CFP, image size 1659x2212, Remidio FOP fundus camera.
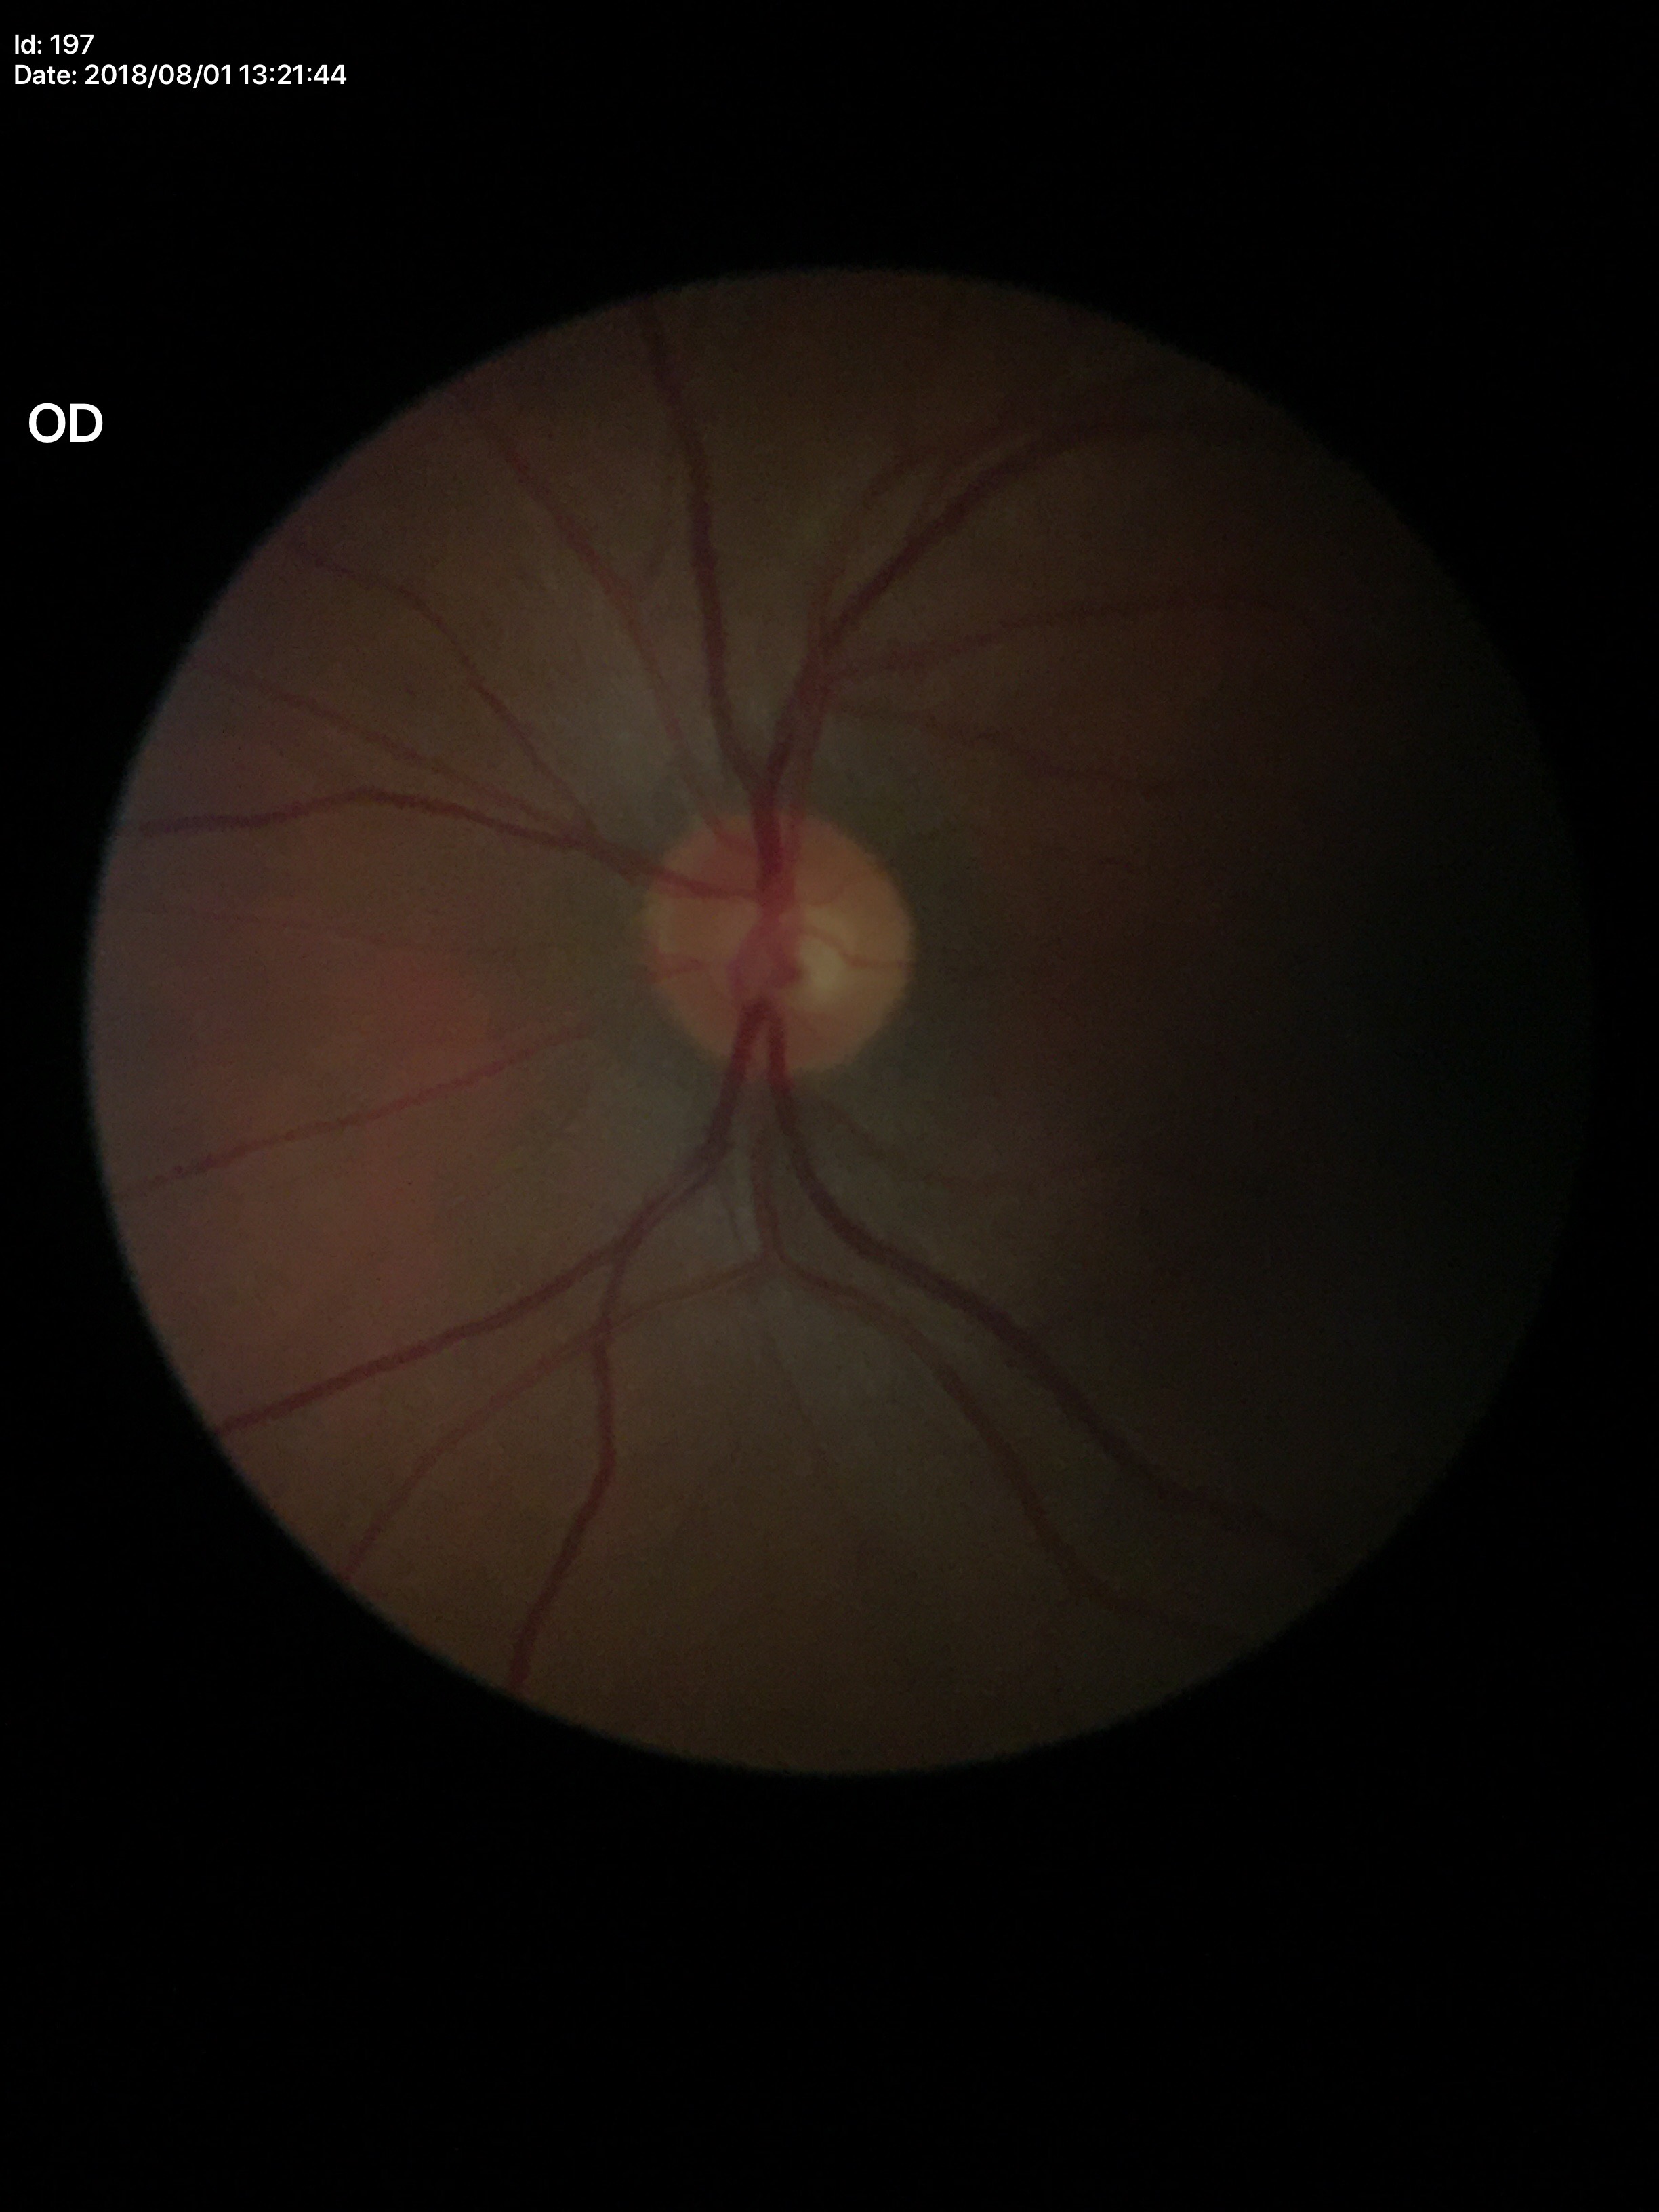
area cup-to-disc ratio = 0.32; Glaucoma assessment = negative; vertical cup-to-disc ratio = 0.53.